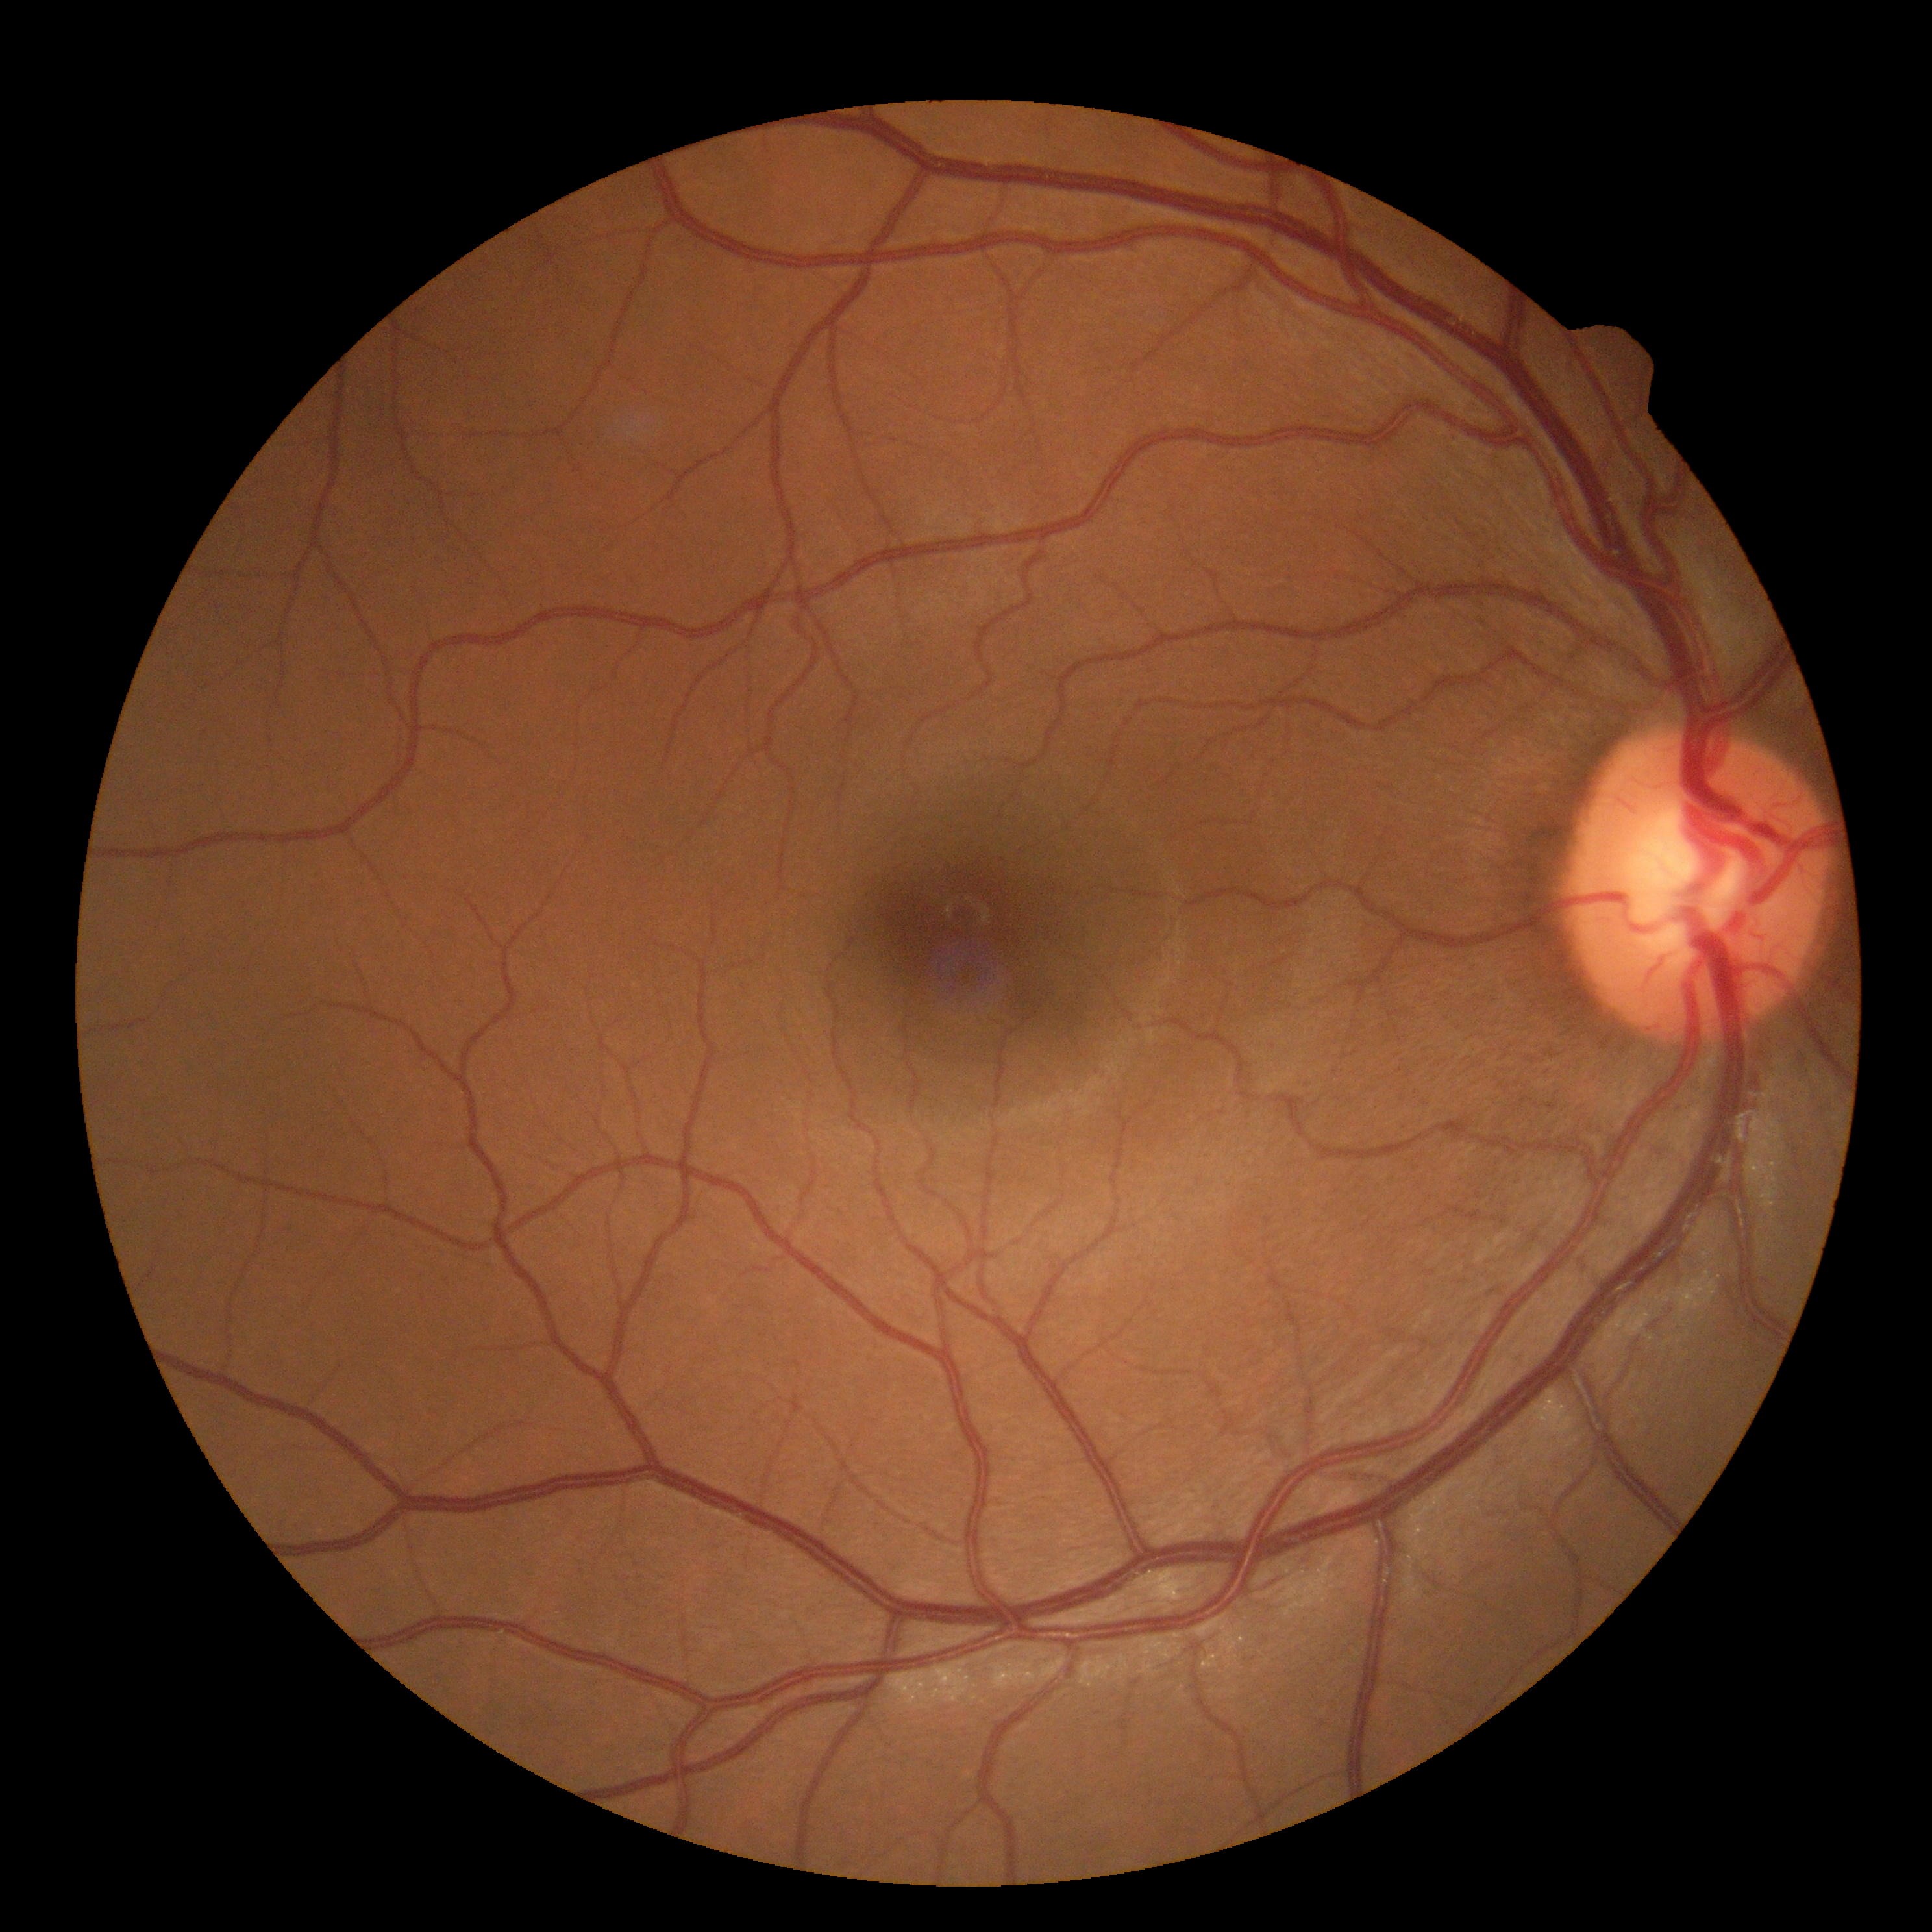
No diabetic retinal disease findings. Diabetic retinopathy: no apparent diabetic retinopathy (grade 0).